Color fundus image; 45° FOV; 1932 by 1916 pixels — 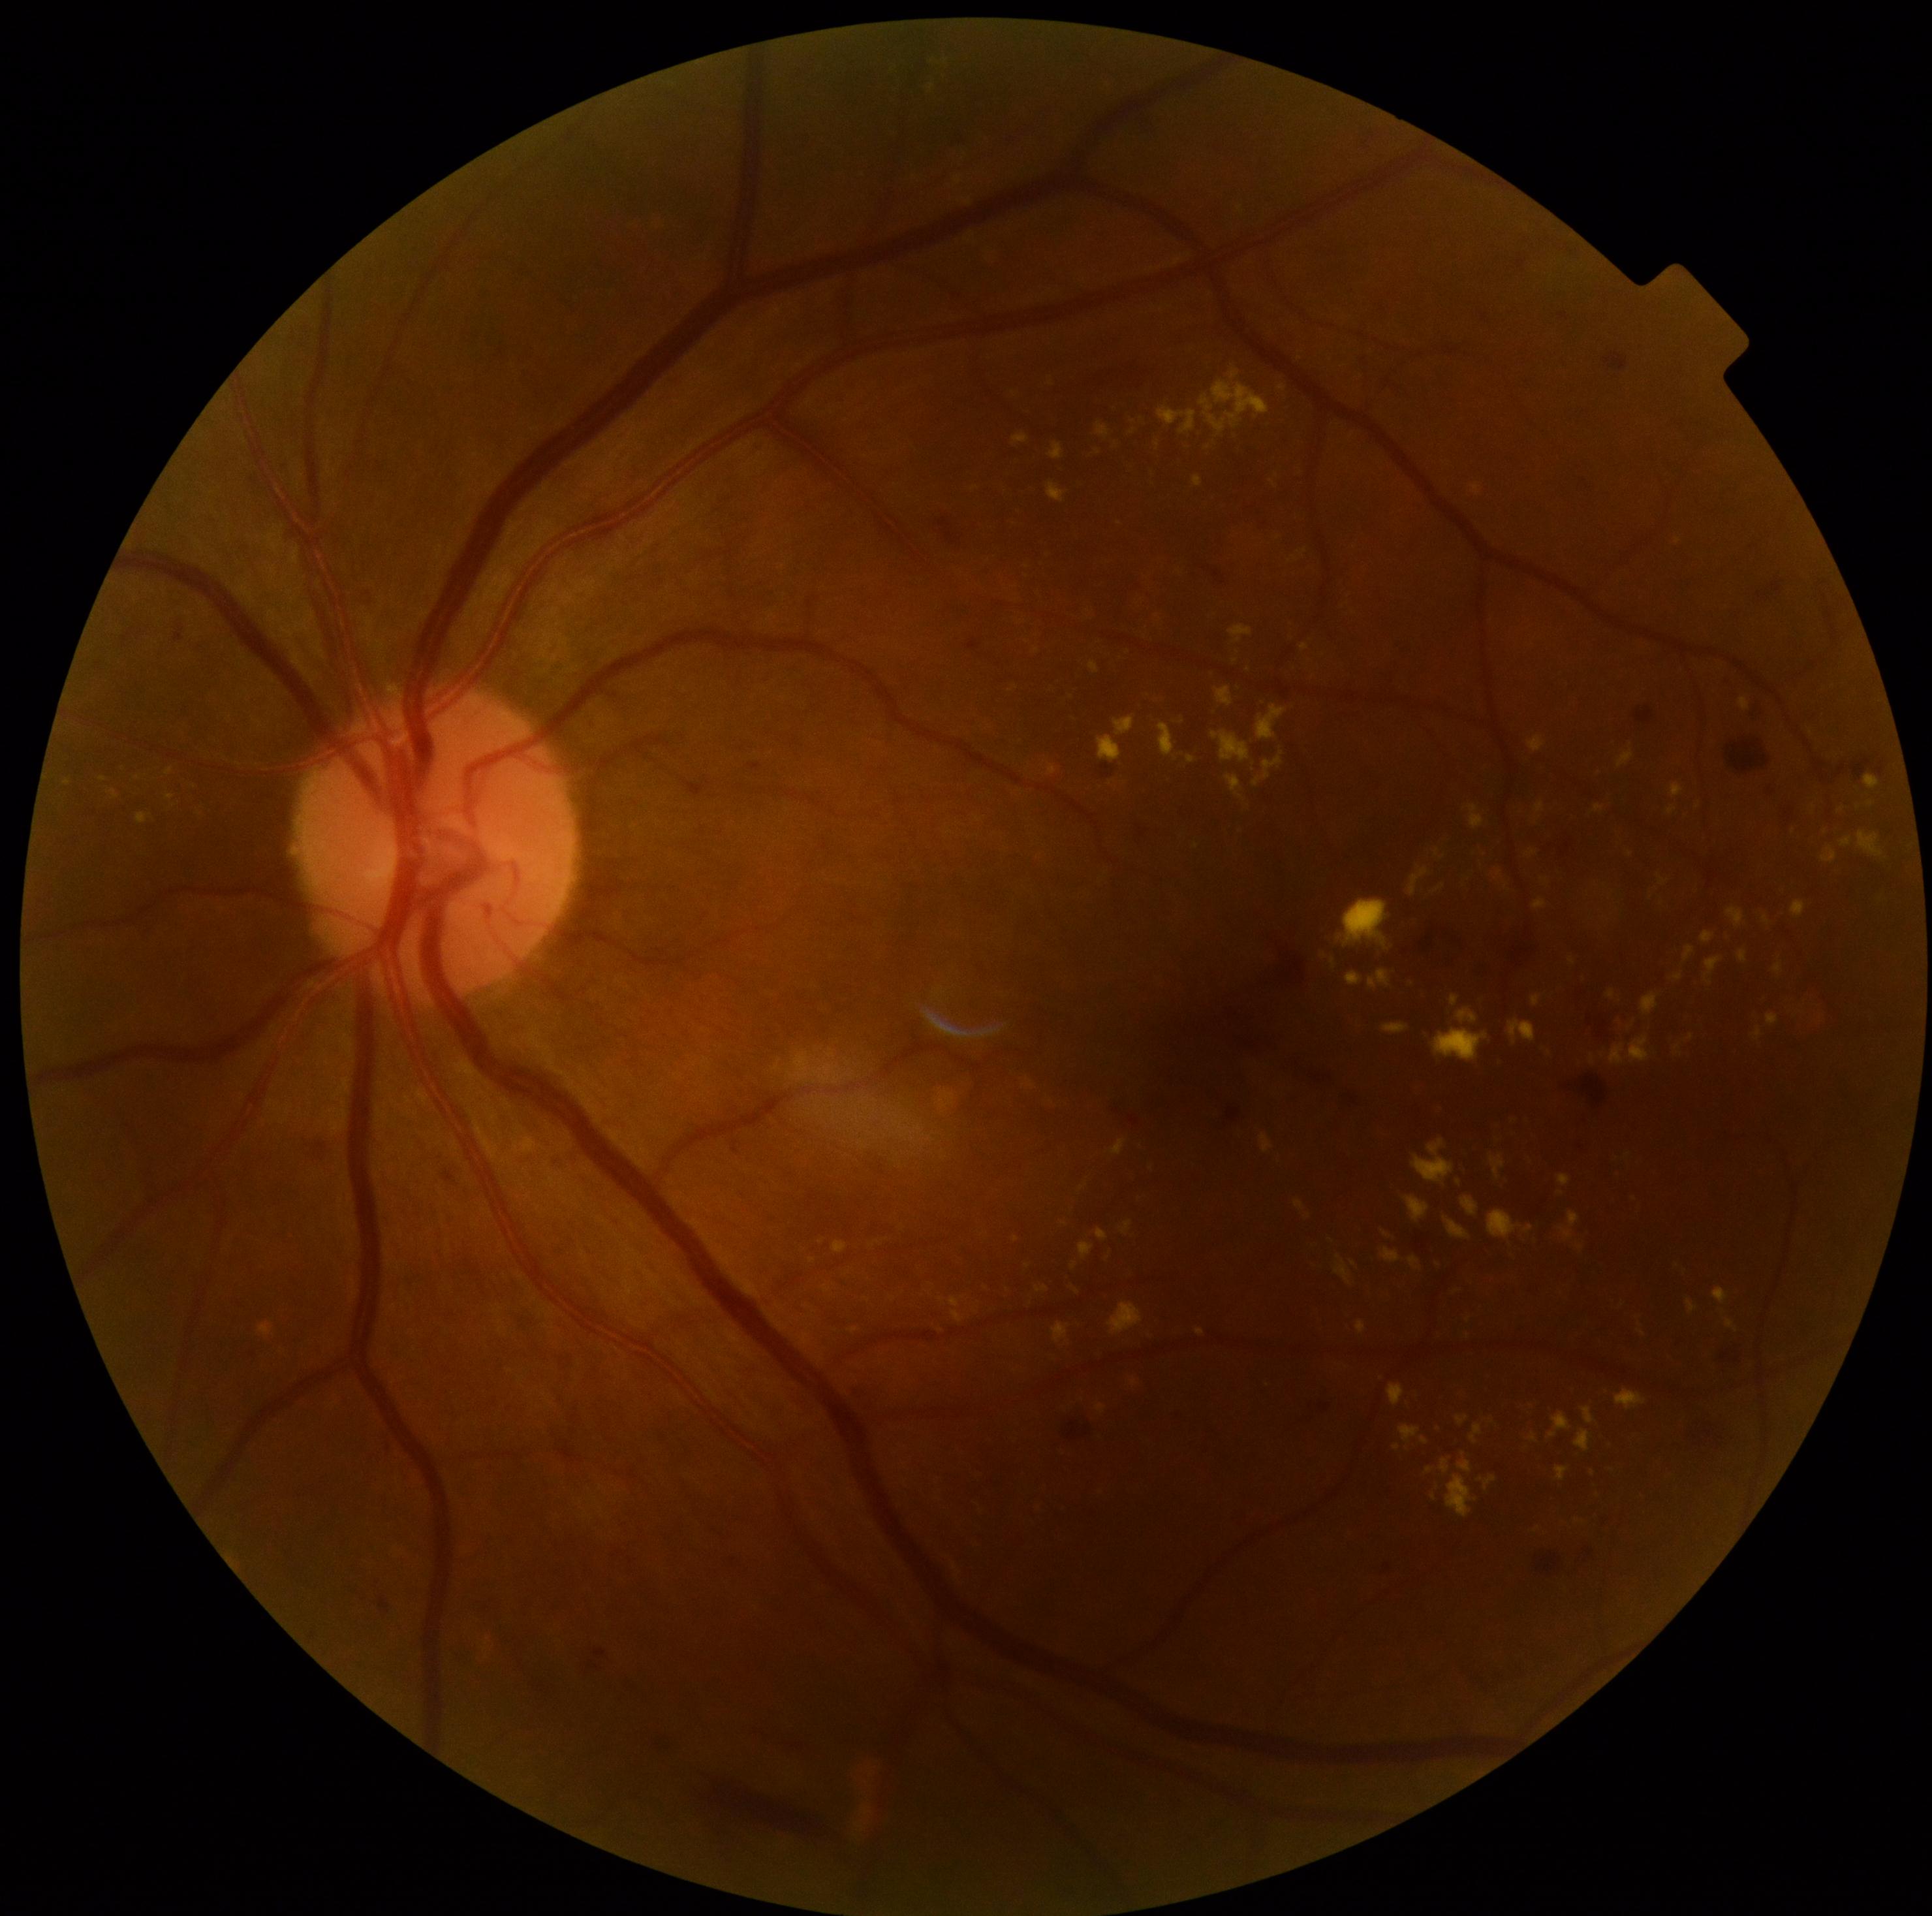 Diabetic retinopathy: 2/4 — more than just microaneurysms but less than severe NPDR; non-proliferative diabetic retinopathy
Representative lesions:
* hard exudates (partial): region(1160, 723, 1178, 760), region(1542, 880, 1550, 884), region(1639, 1329, 1647, 1336), region(1529, 1434, 1538, 1443), region(1212, 730, 1251, 764), region(1525, 850, 1537, 859), region(800, 1333, 811, 1346), region(259, 1321, 273, 1336), region(1400, 1426, 1421, 1444), region(1840, 837, 1853, 847), region(1426, 1466, 1434, 1474), region(1792, 900, 1807, 919), region(1050, 443, 1065, 460), region(1113, 715, 1135, 736)
* Additional small hard exudates near <point>1183, 723</point>, <point>68, 783</point>, <point>1437, 853</point>, <point>1235, 661</point>